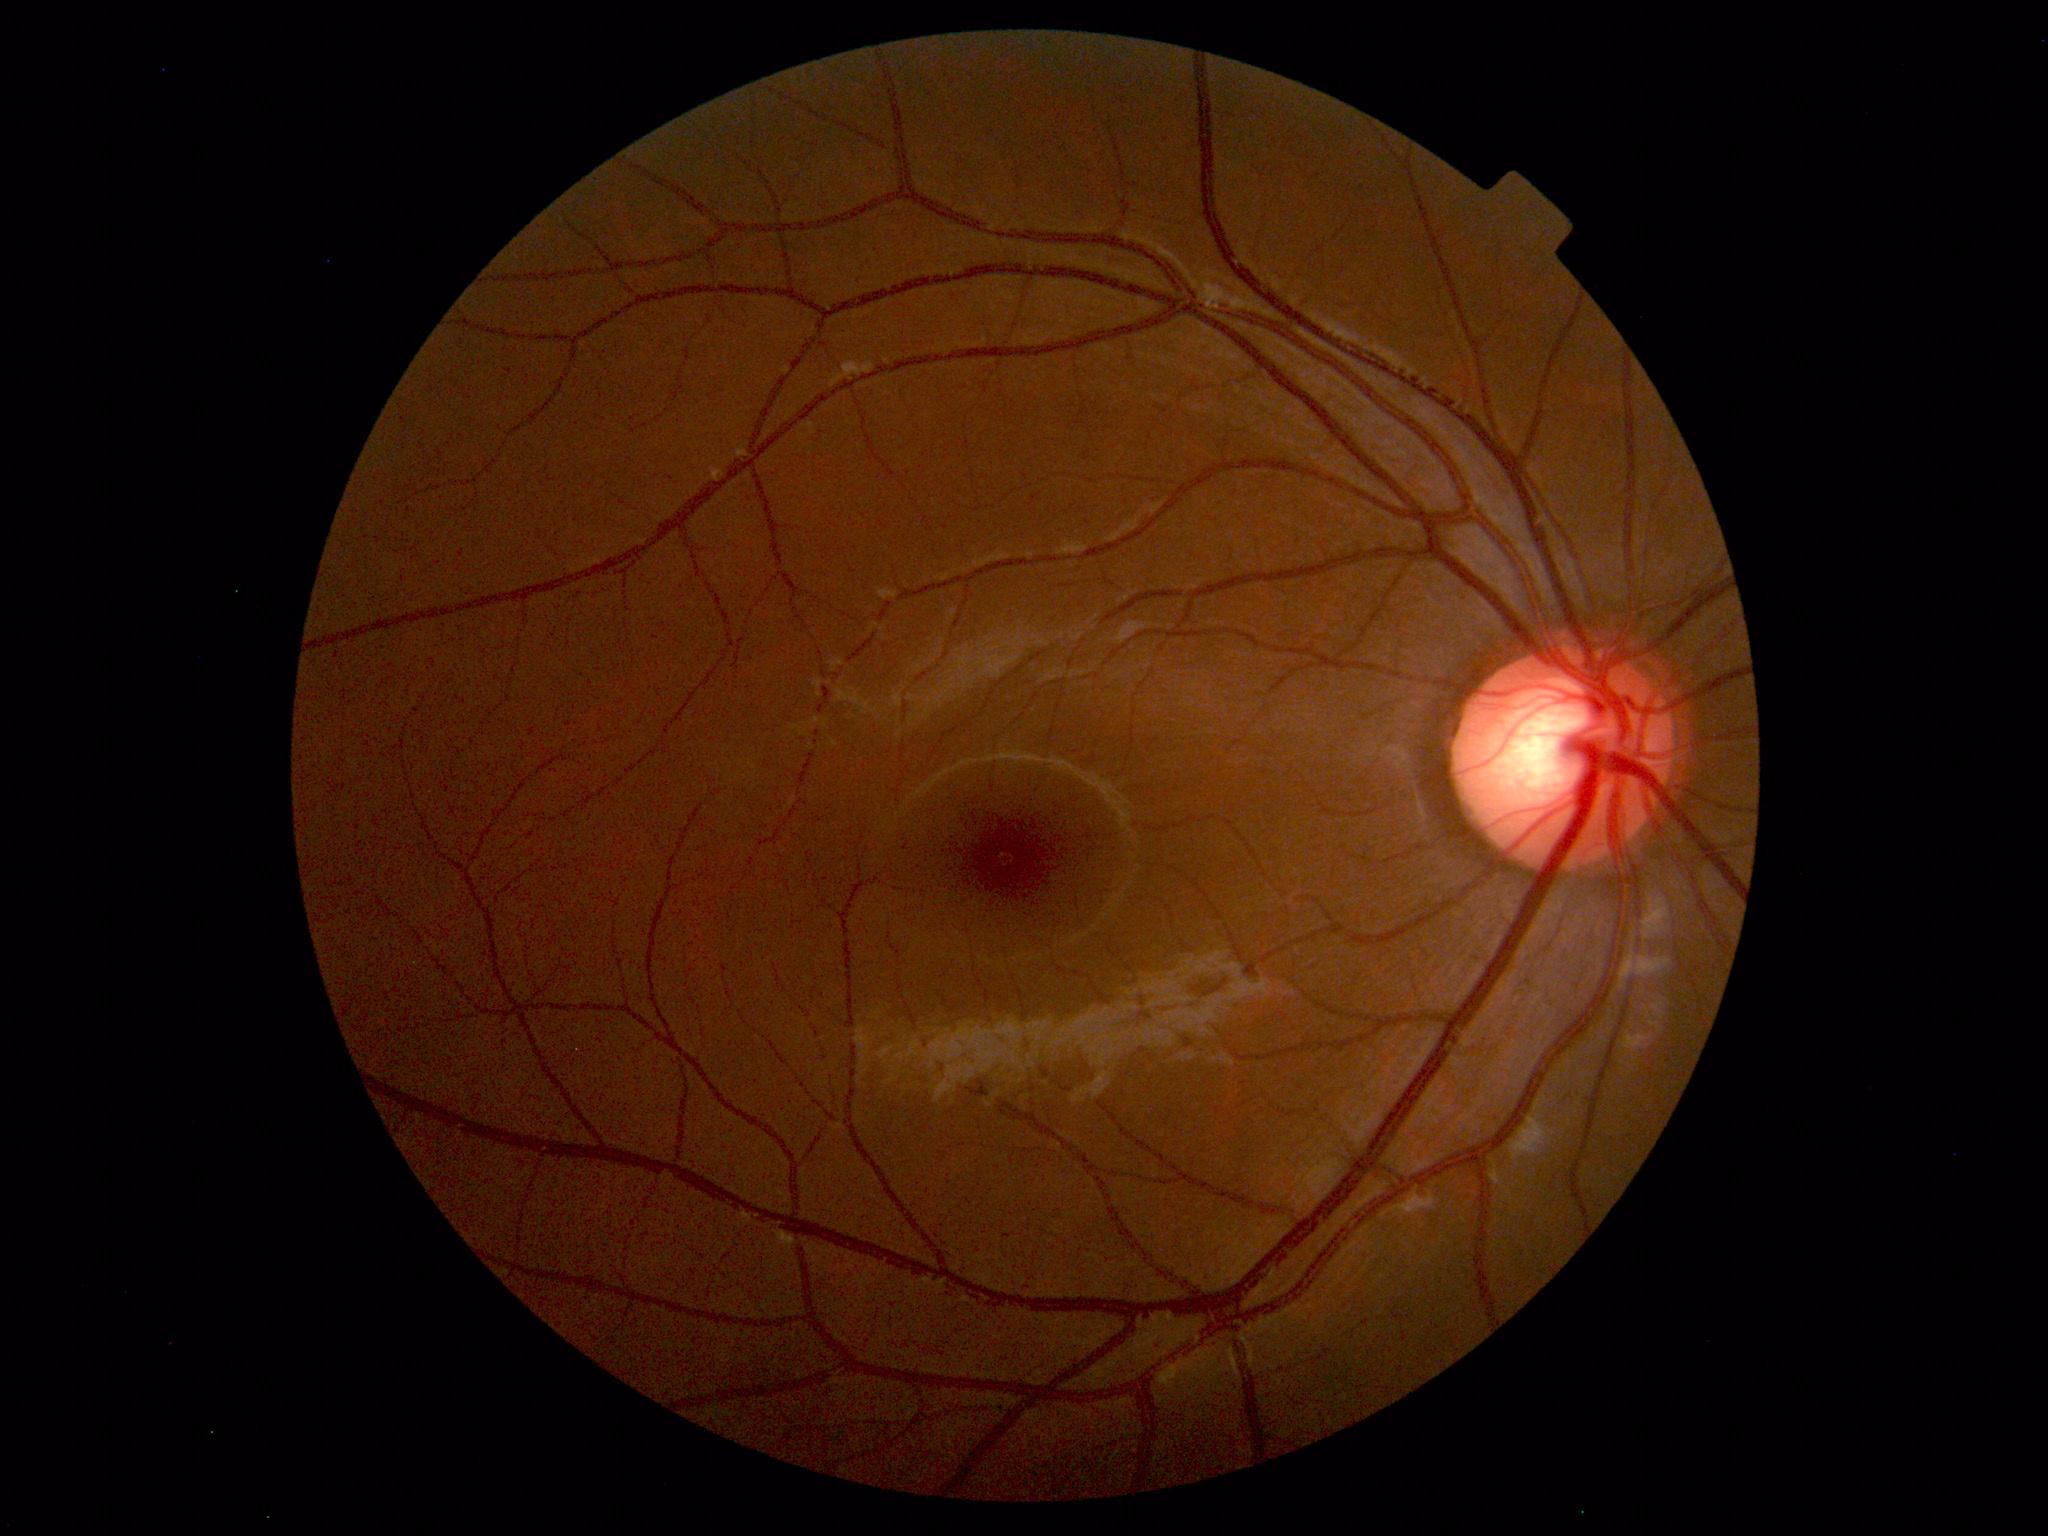

Normal fundus appearance.